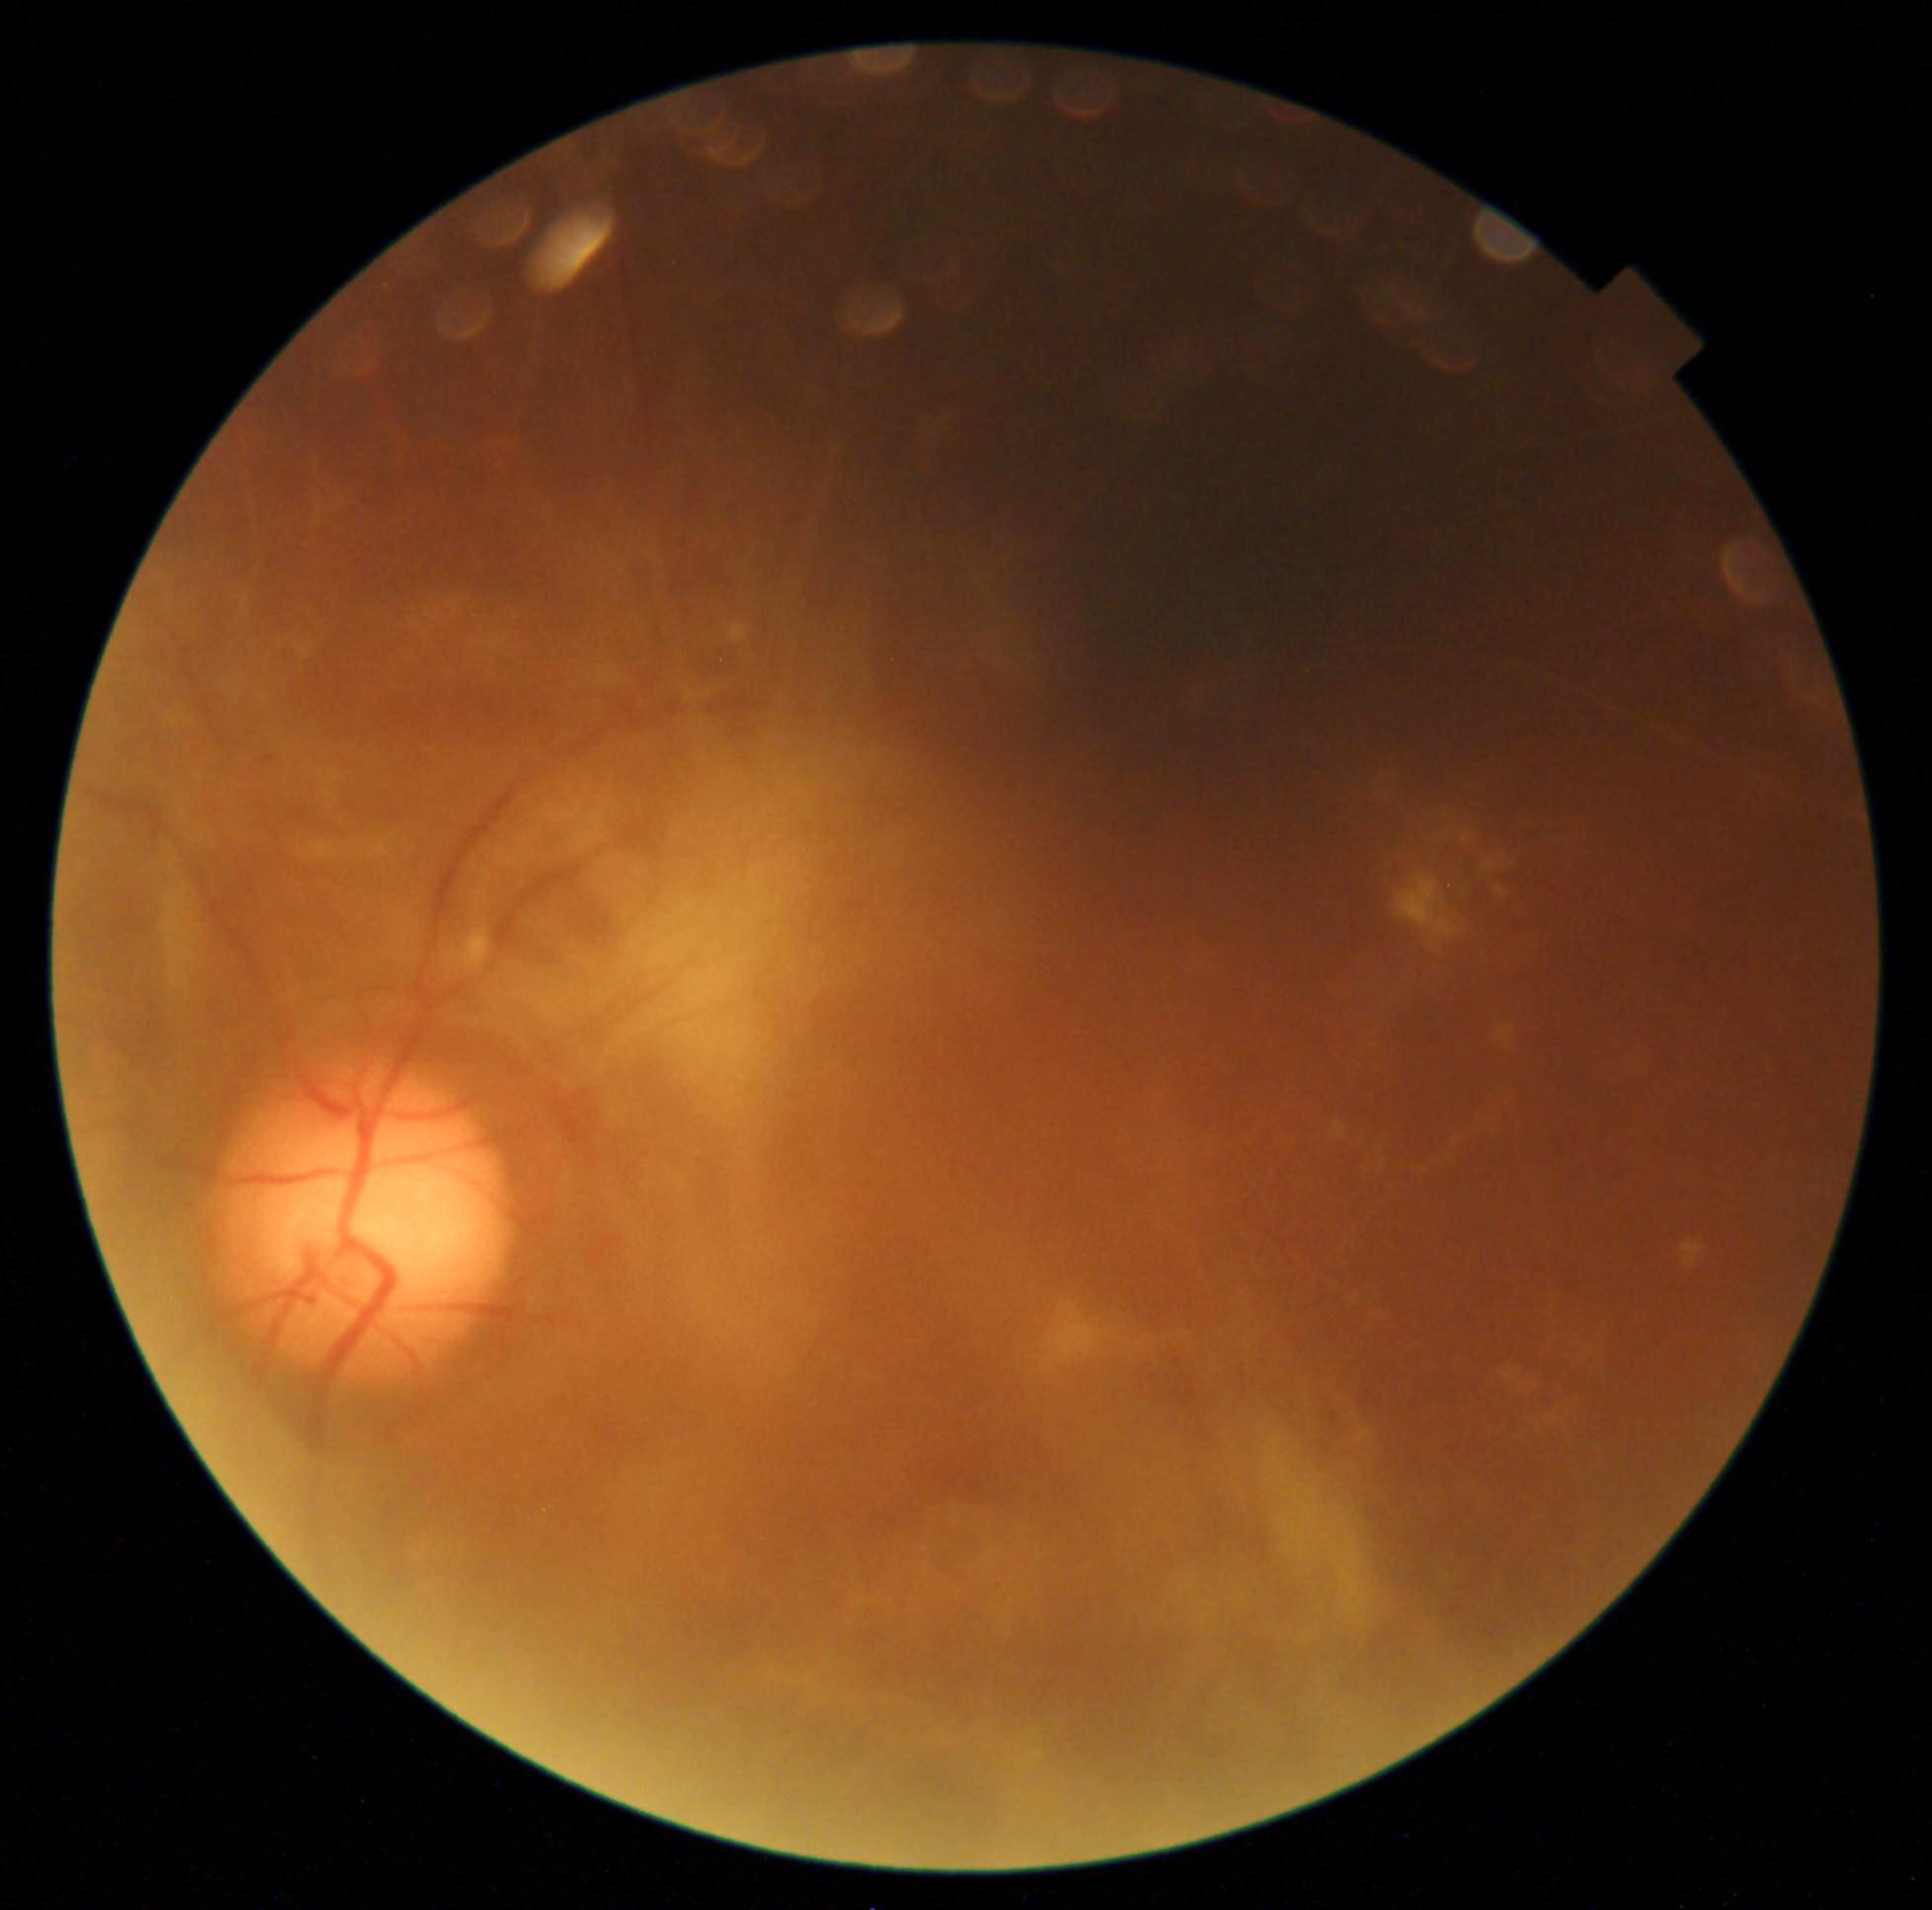 {
  "dr_category": "proliferative diabetic retinopathy",
  "dr_grade": "grade 4 (PDR)"
}